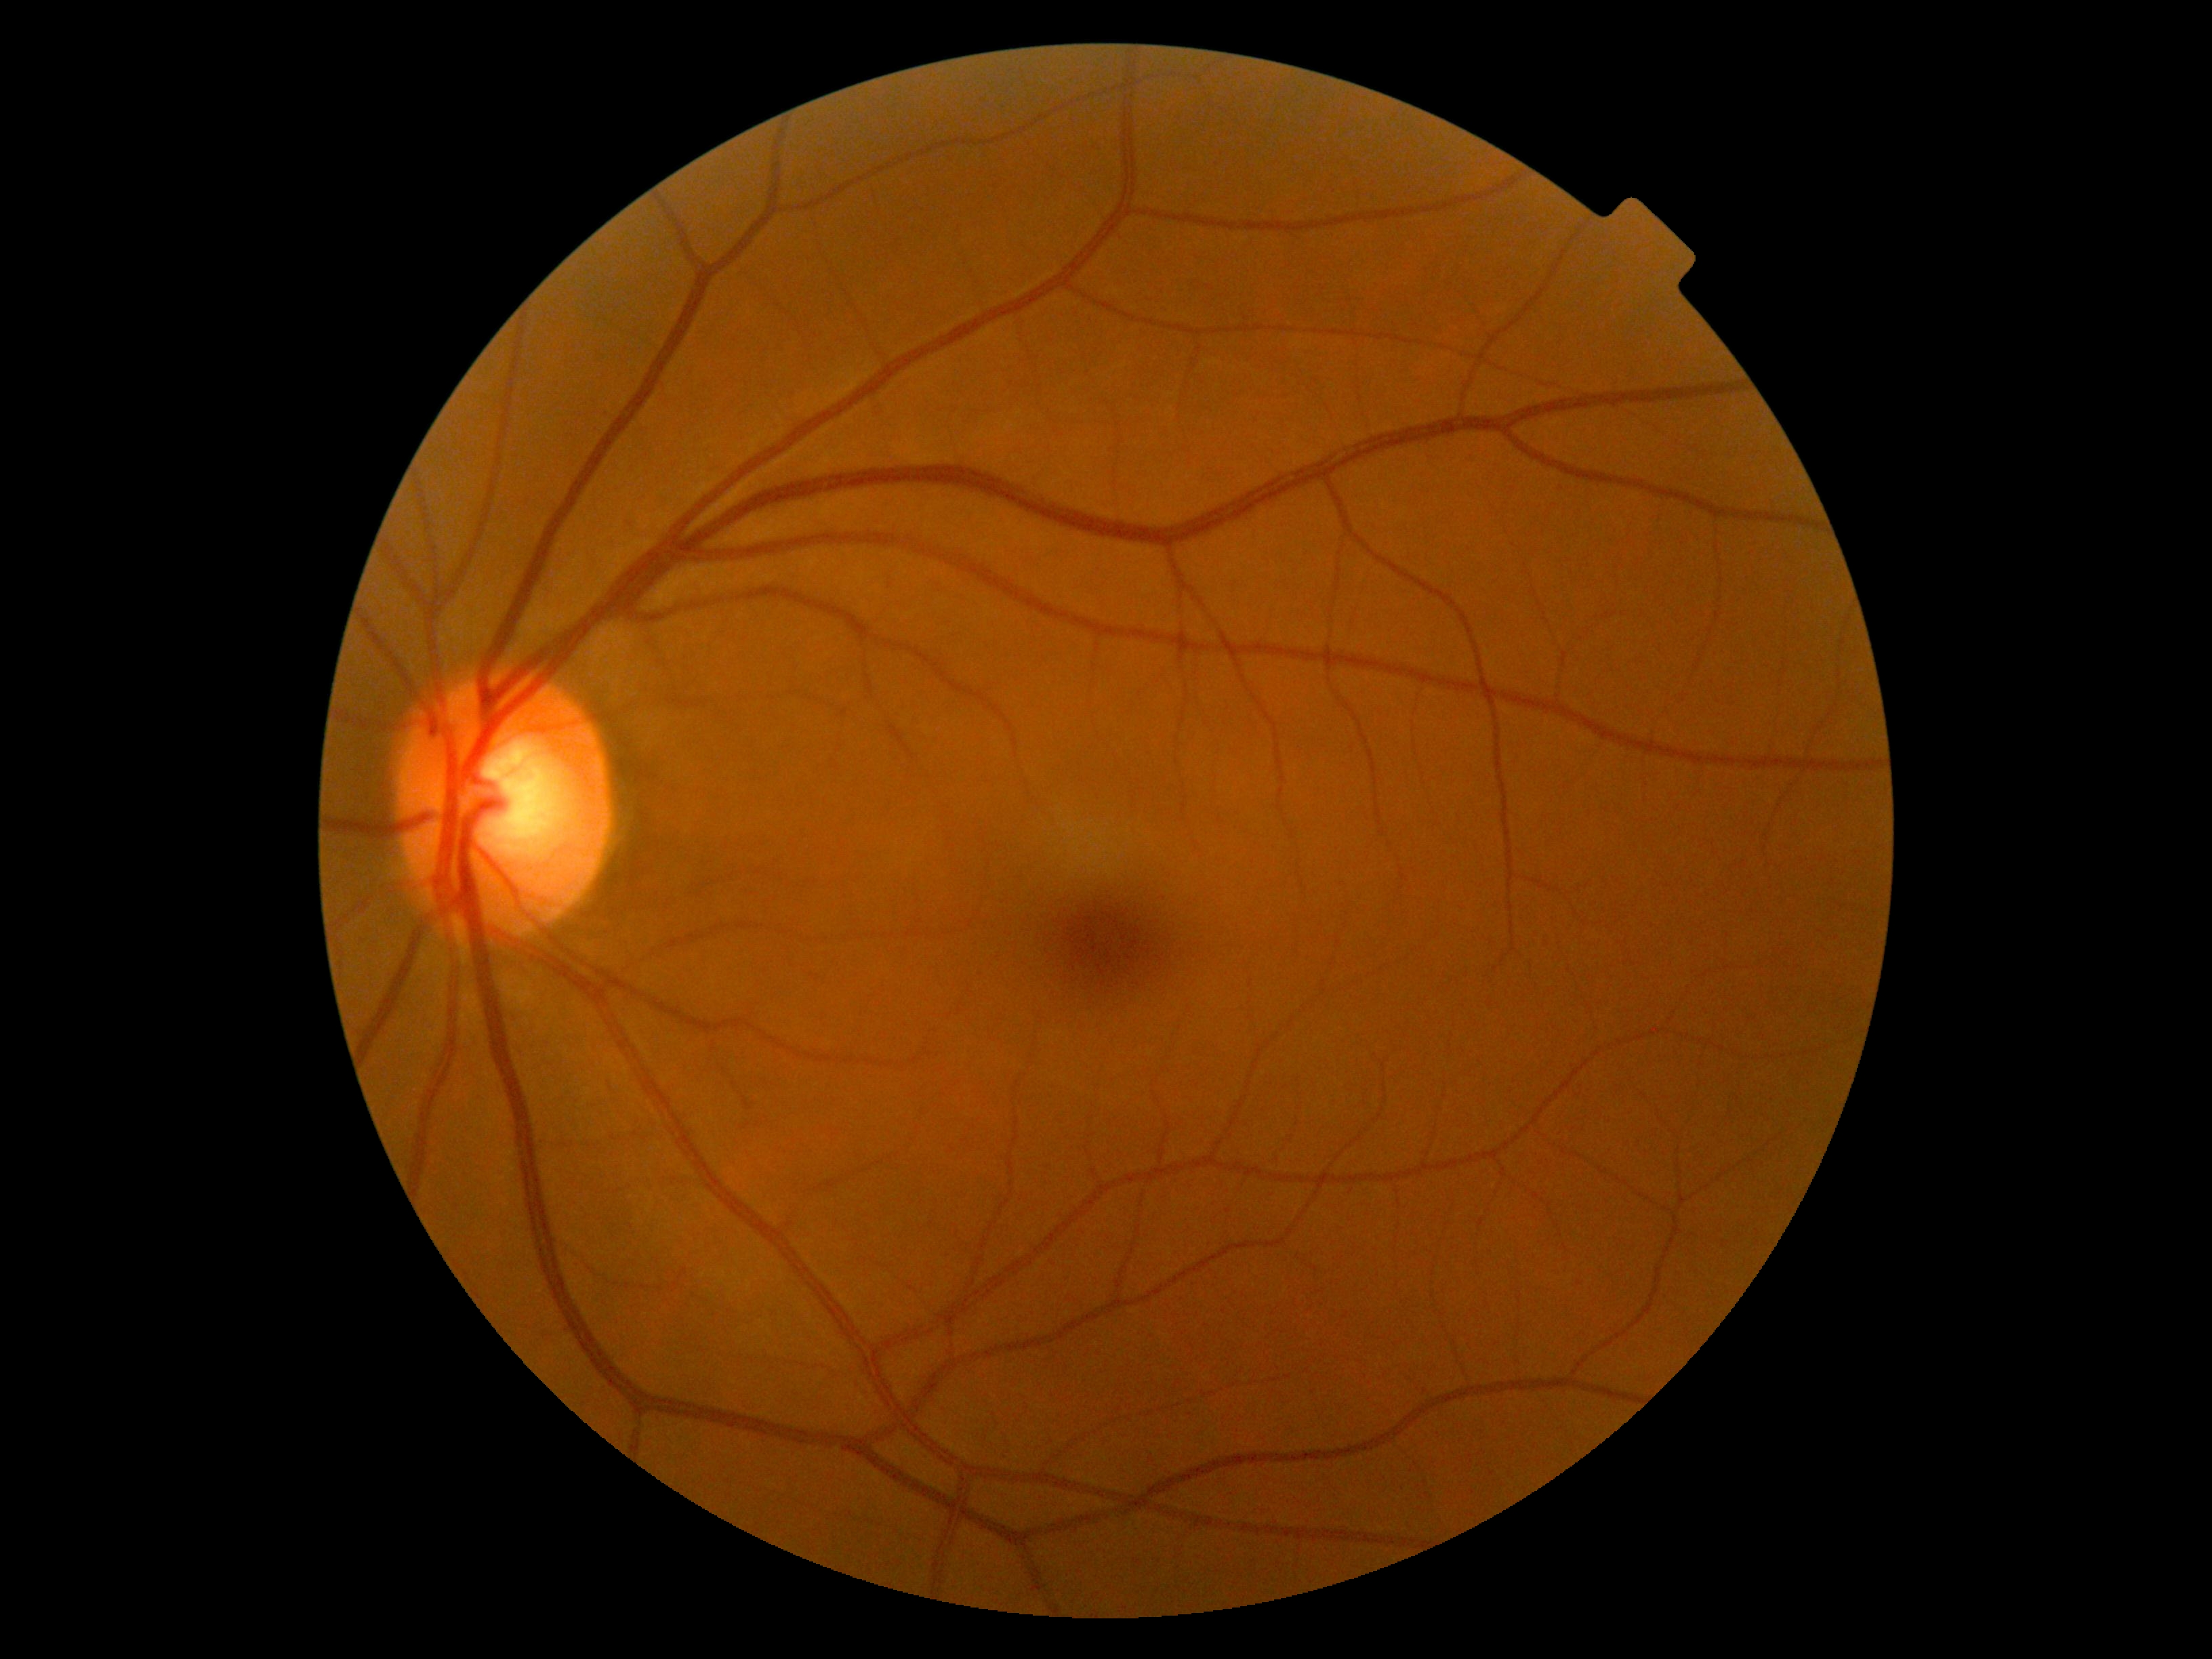
DR grade is 0. No signs of diabetic retinopathy.